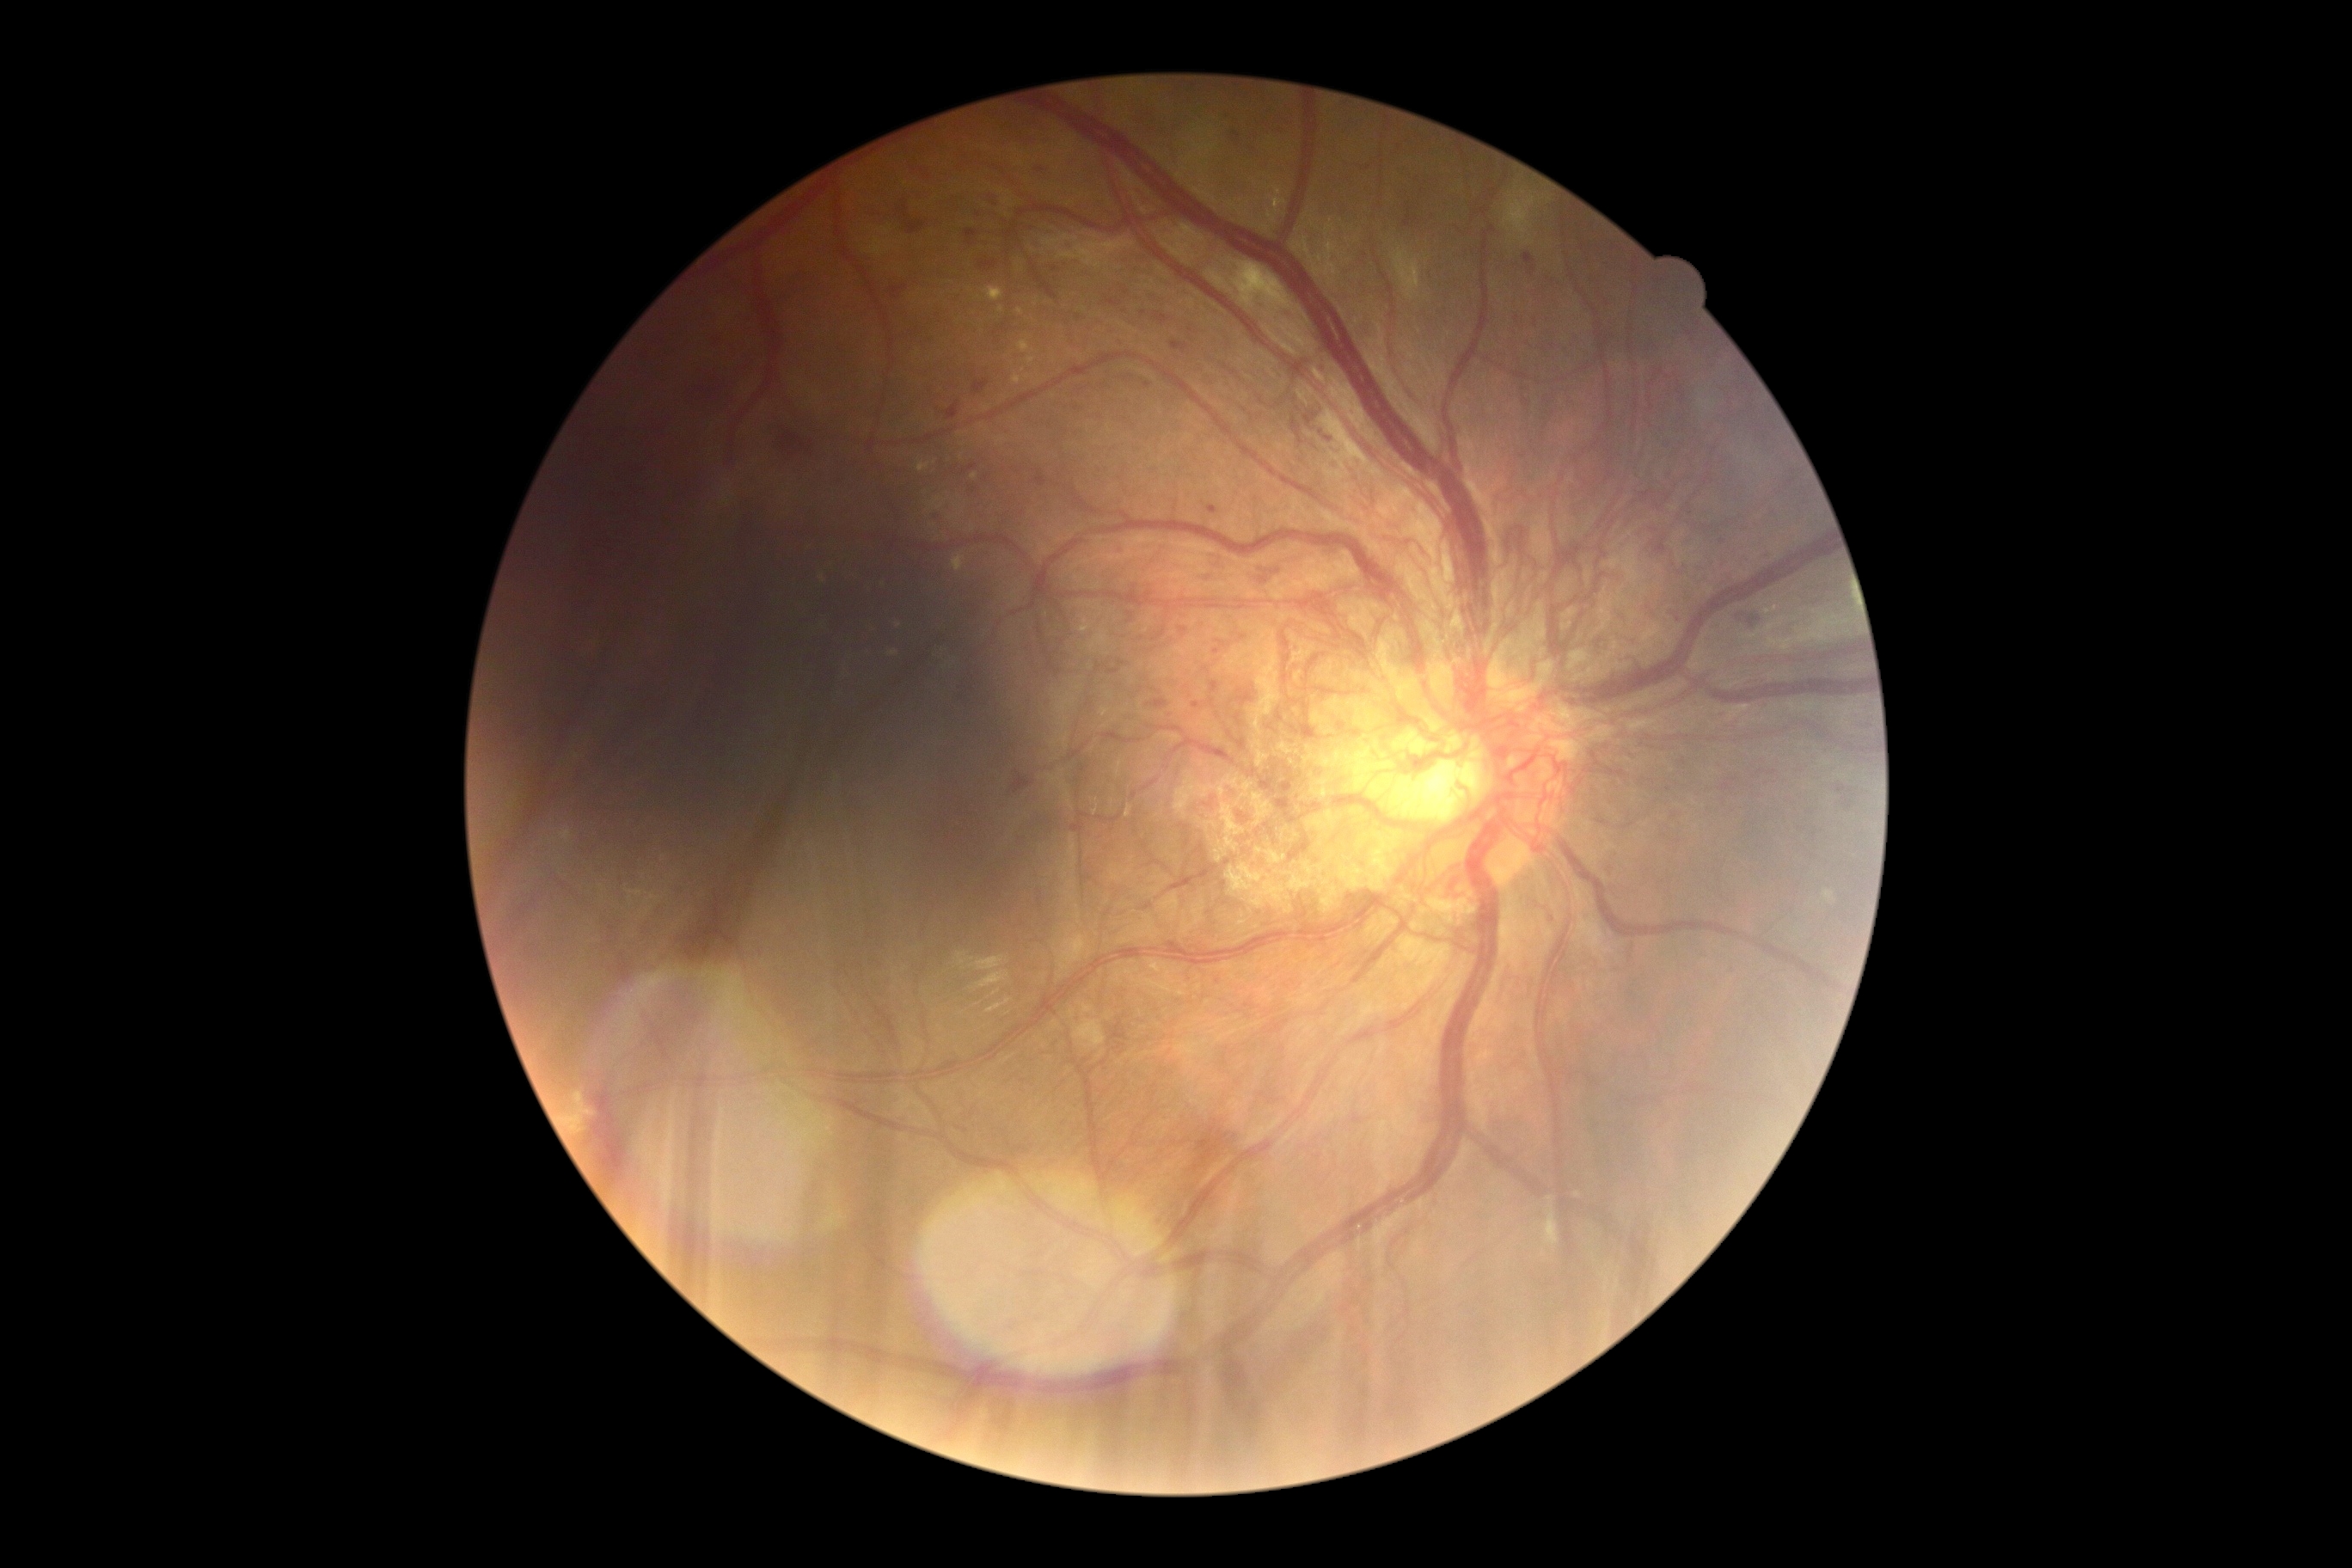
Retinopathy is grade 4. Disease class: proliferative diabetic retinopathy.